Camera: NIDEK AFC-230.
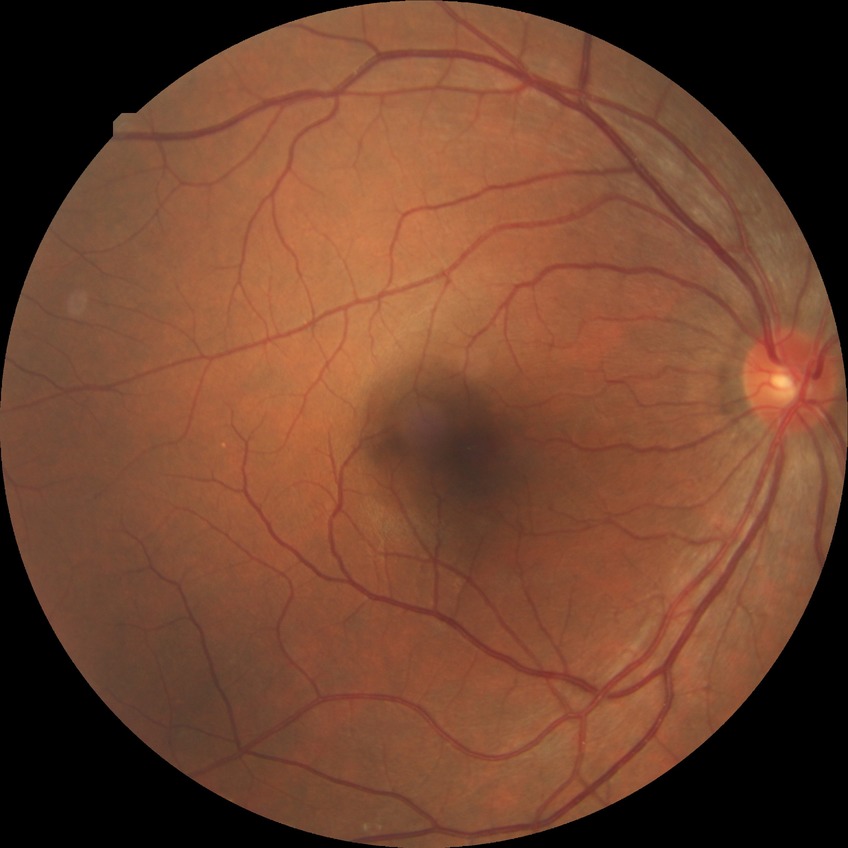
diabetic retinopathy (DR)=NDR (no diabetic retinopathy).